Acquired with a NIDEK AFC-230 · color fundus image: 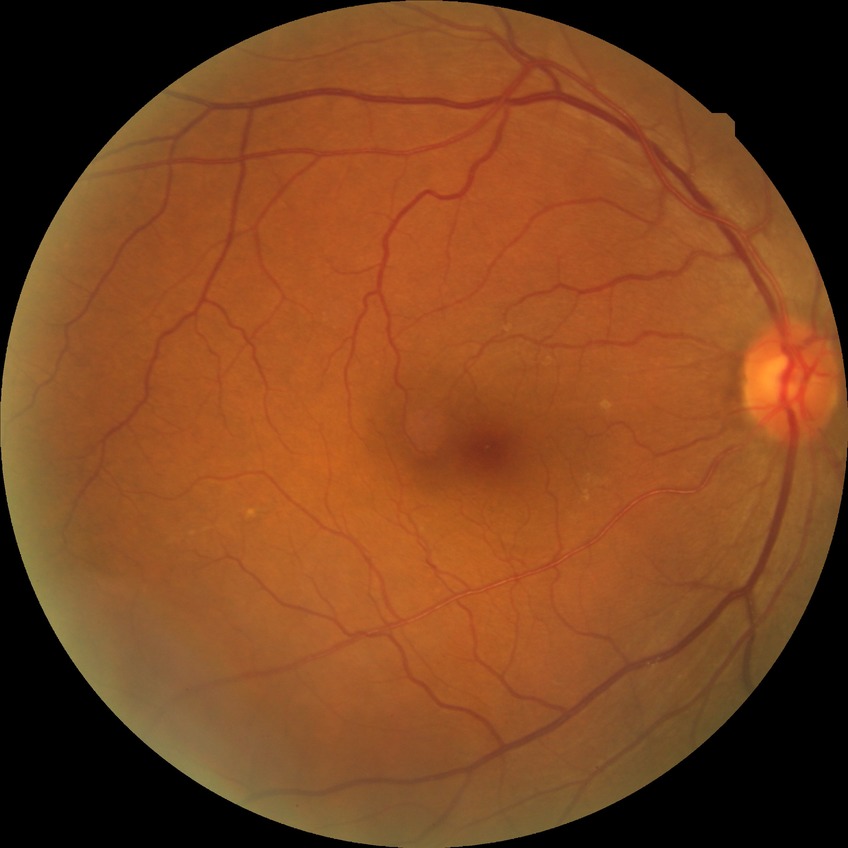
Diabetic retinopathy severity: no diabetic retinopathy.